Color fundus image: 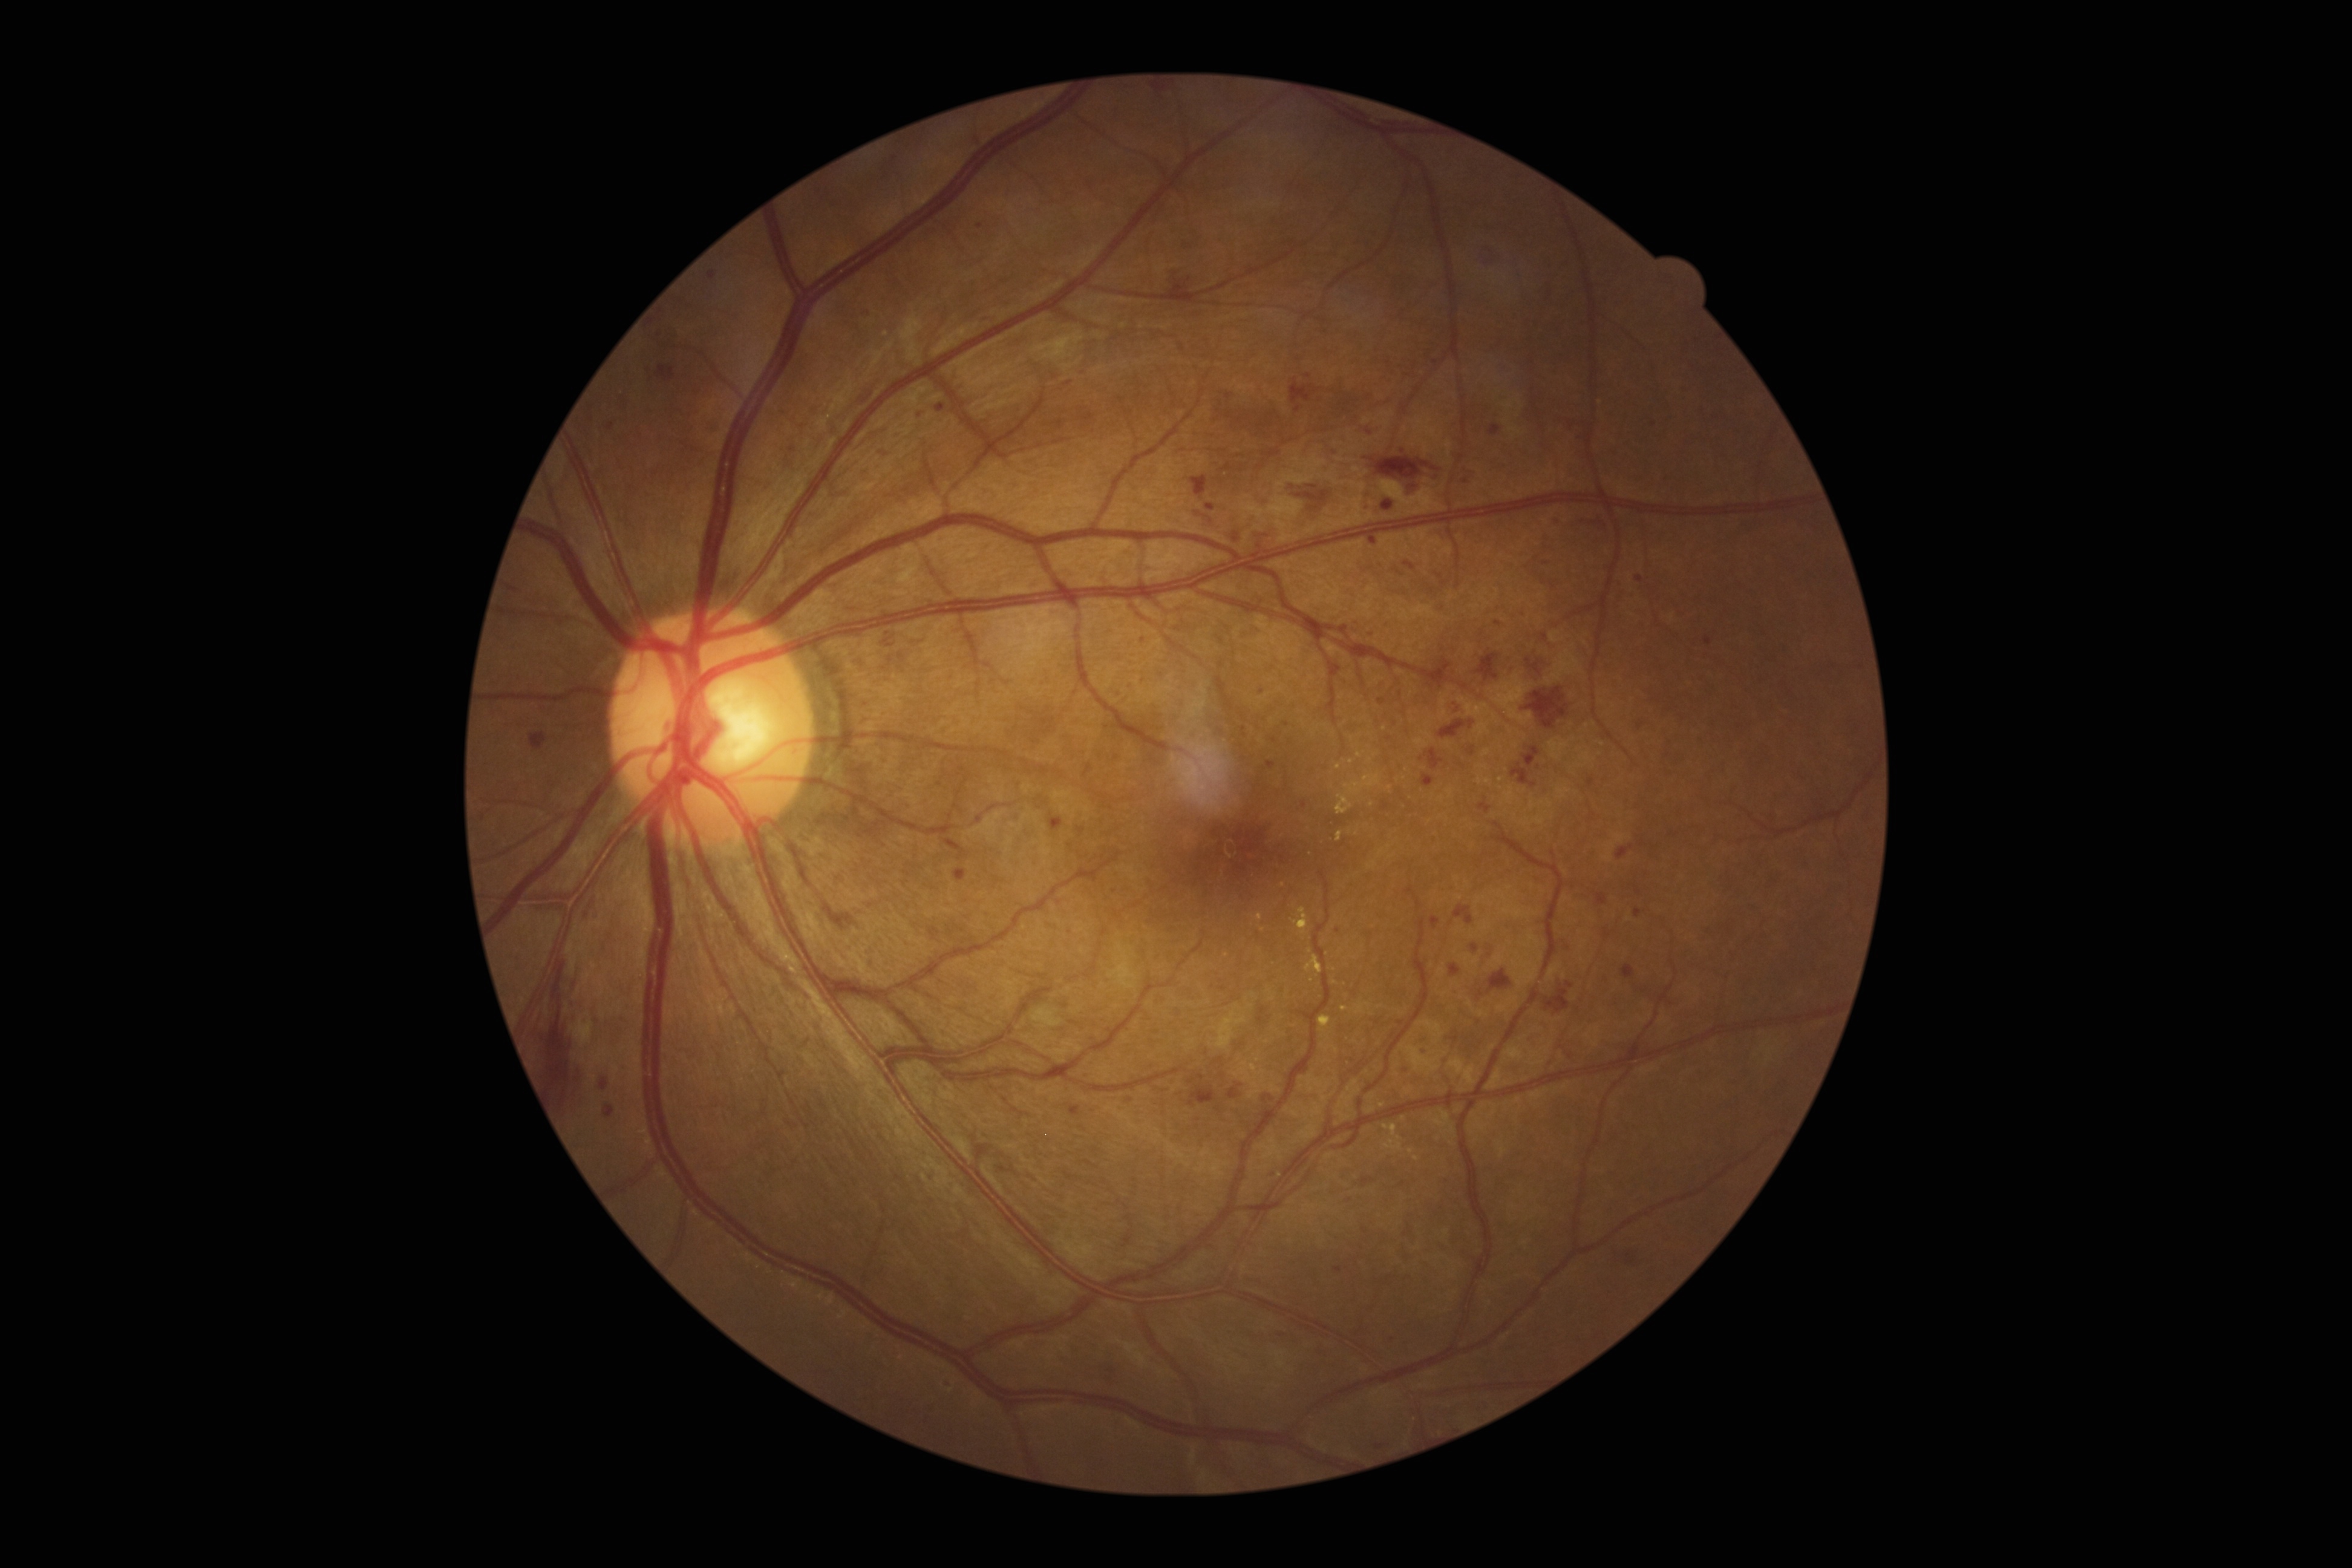

Findings:
• DR — grade 3 (severe NPDR)